130° field of view (Clarity RetCam 3). RetCam wide-field infant fundus image
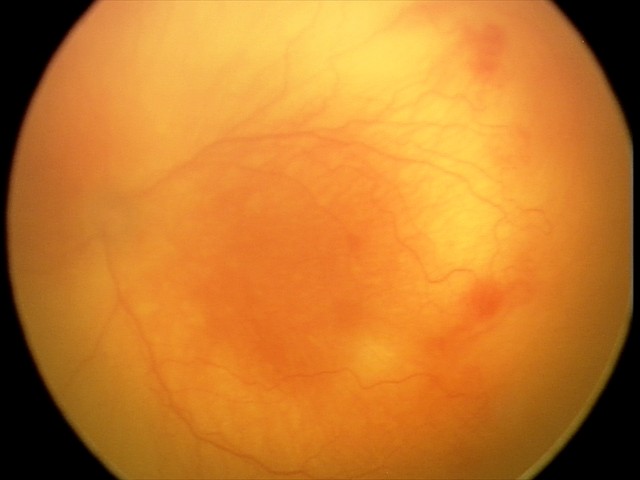 Screening examination consistent with aggressive retinopathy of prematurity (A-ROP).